45-degree field of view; without pupil dilation — 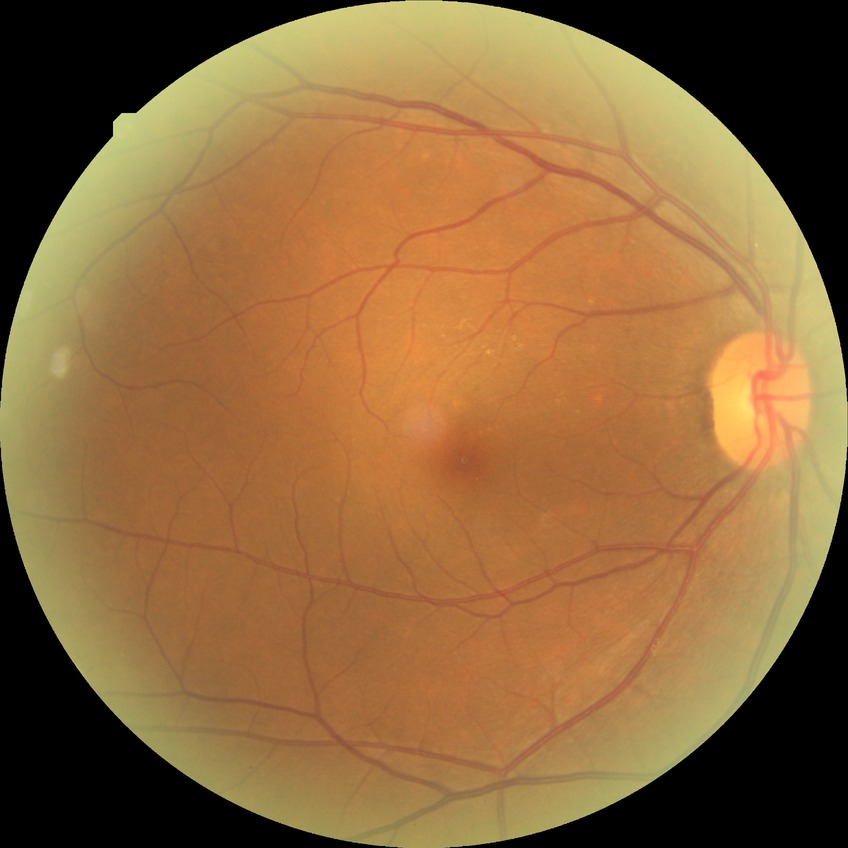

diabetic retinopathy grade = no diabetic retinopathy